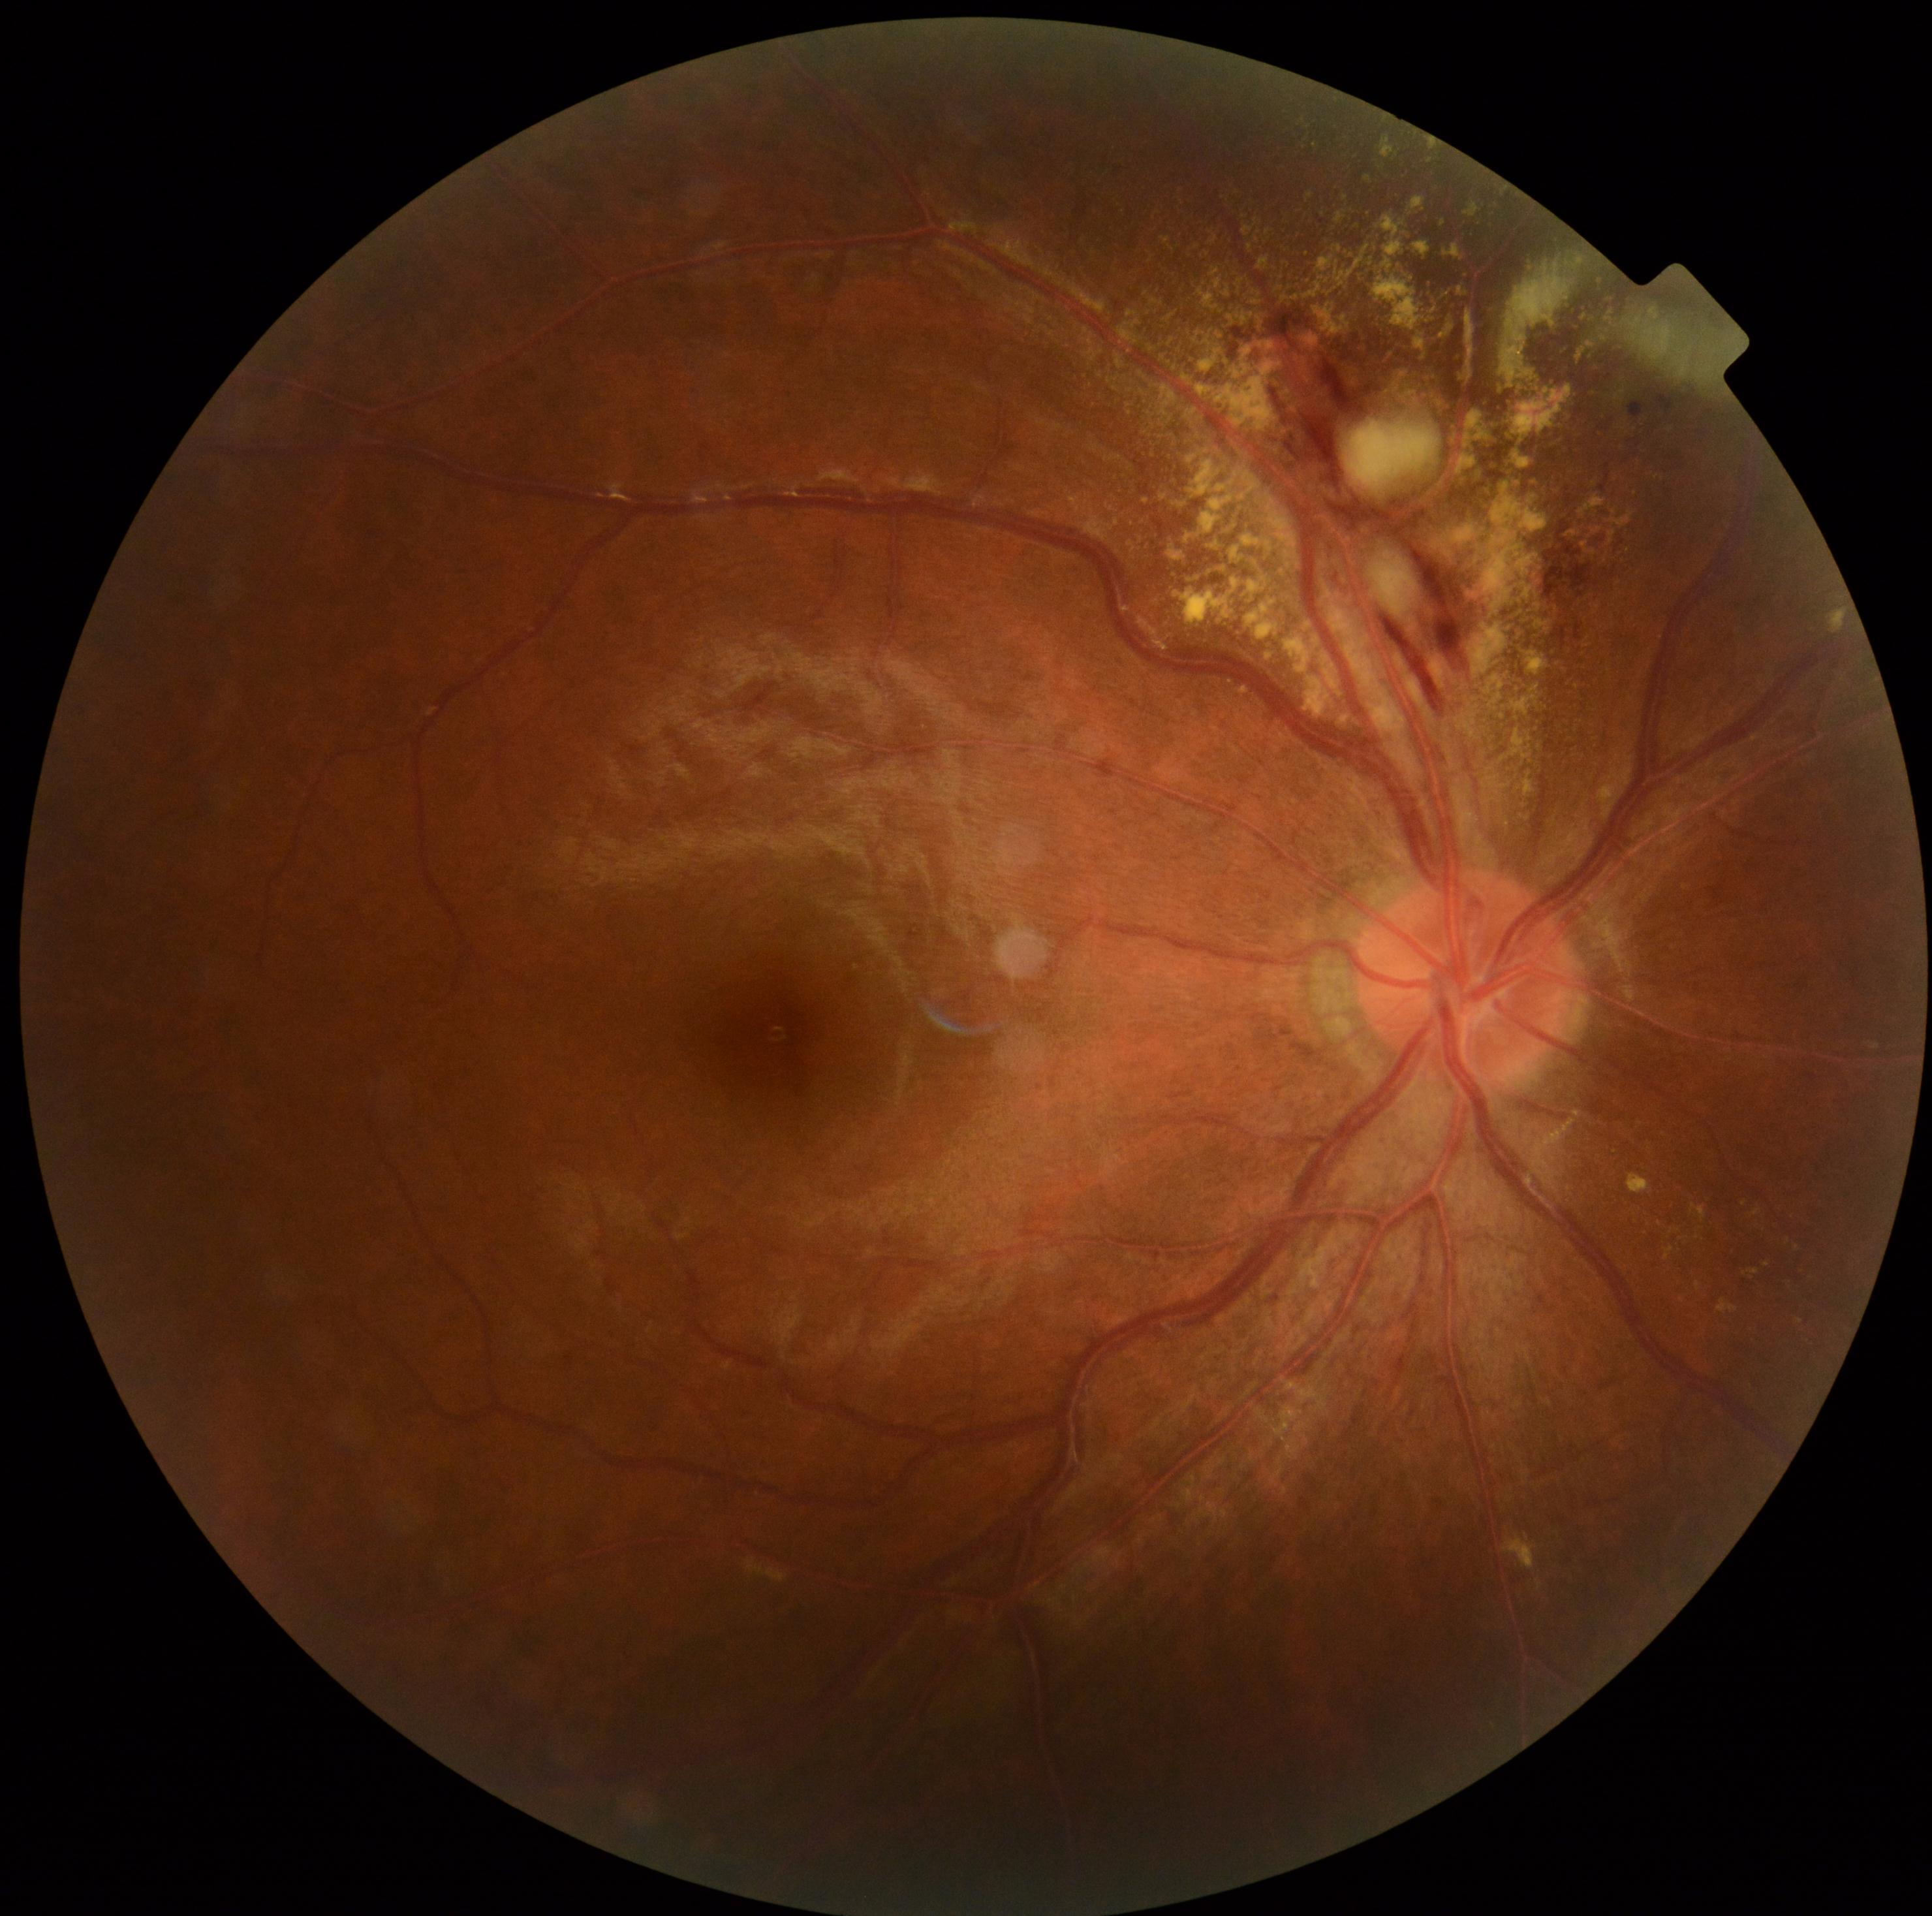 diabetic retinopathy (DR) = grade 2 (moderate NPDR).